Disc-centered field — 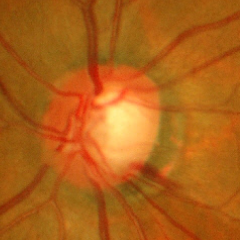

Glaucomatous changes are present. Glaucoma assessment = early glaucomatous optic neuropathy.